Color fundus image. 45-degree field of view. 1536 x 1152 pixels:
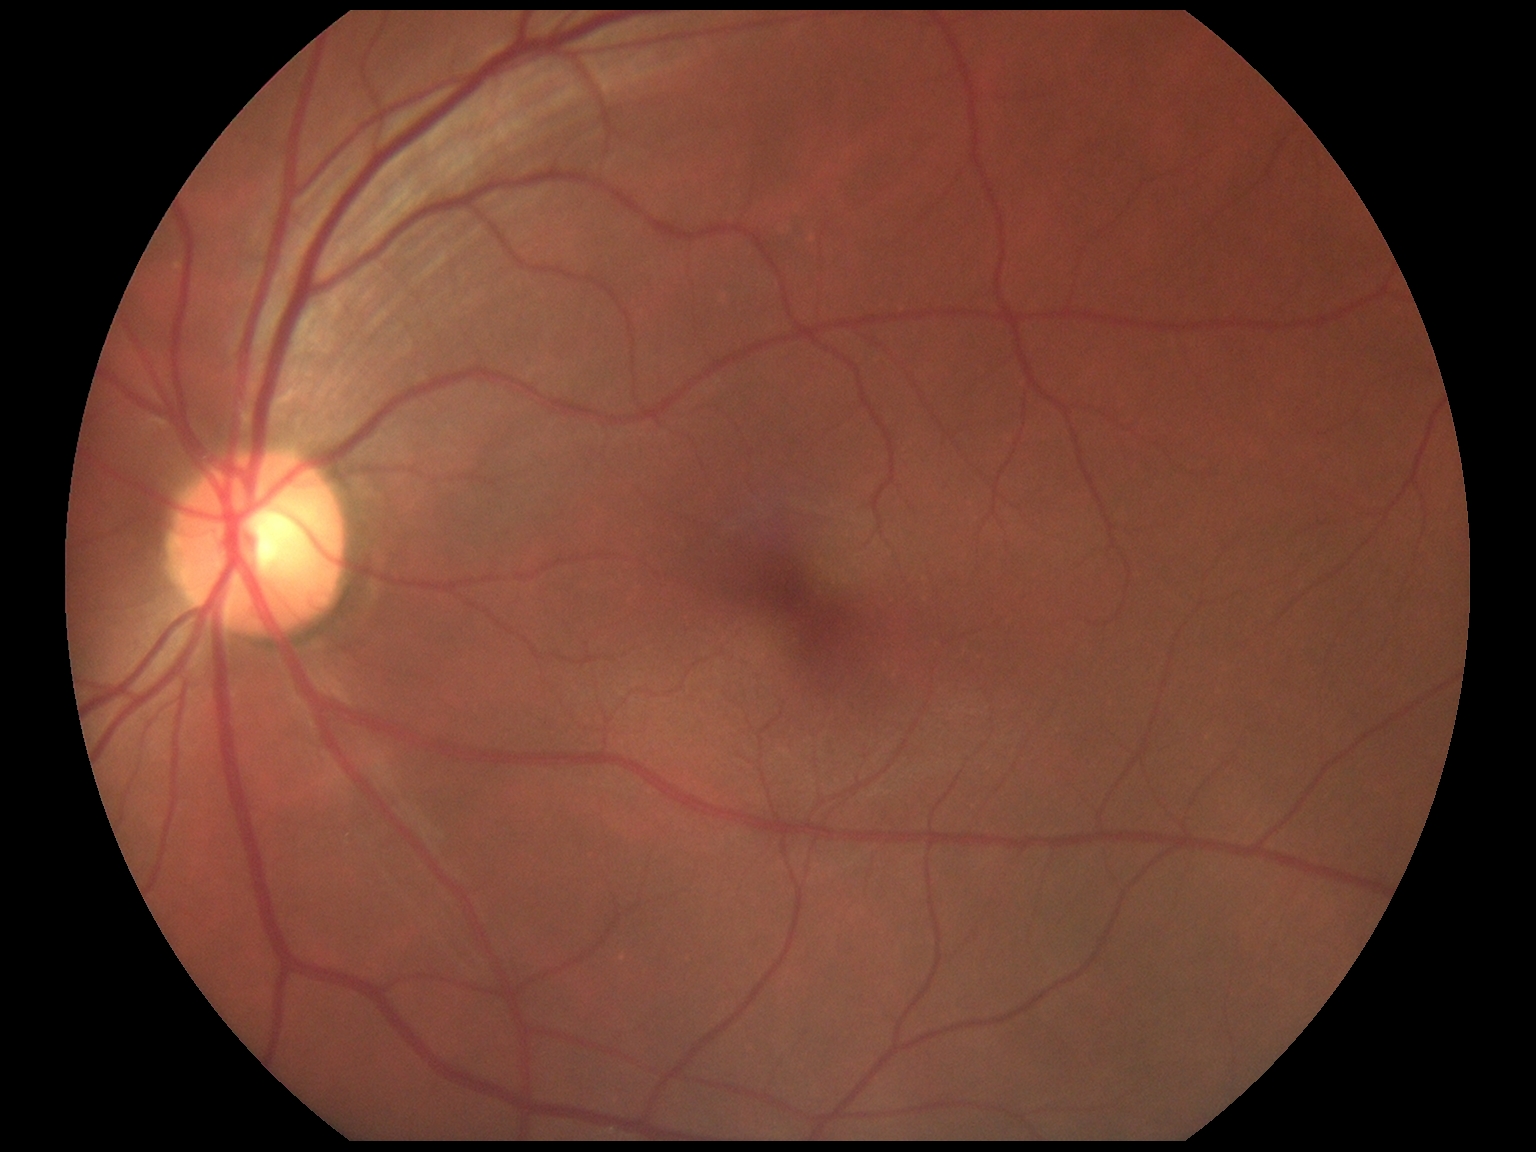

Diabetic retinopathy (DR): no apparent diabetic retinopathy (grade 0).